Ultra-widefield fundus photograph:
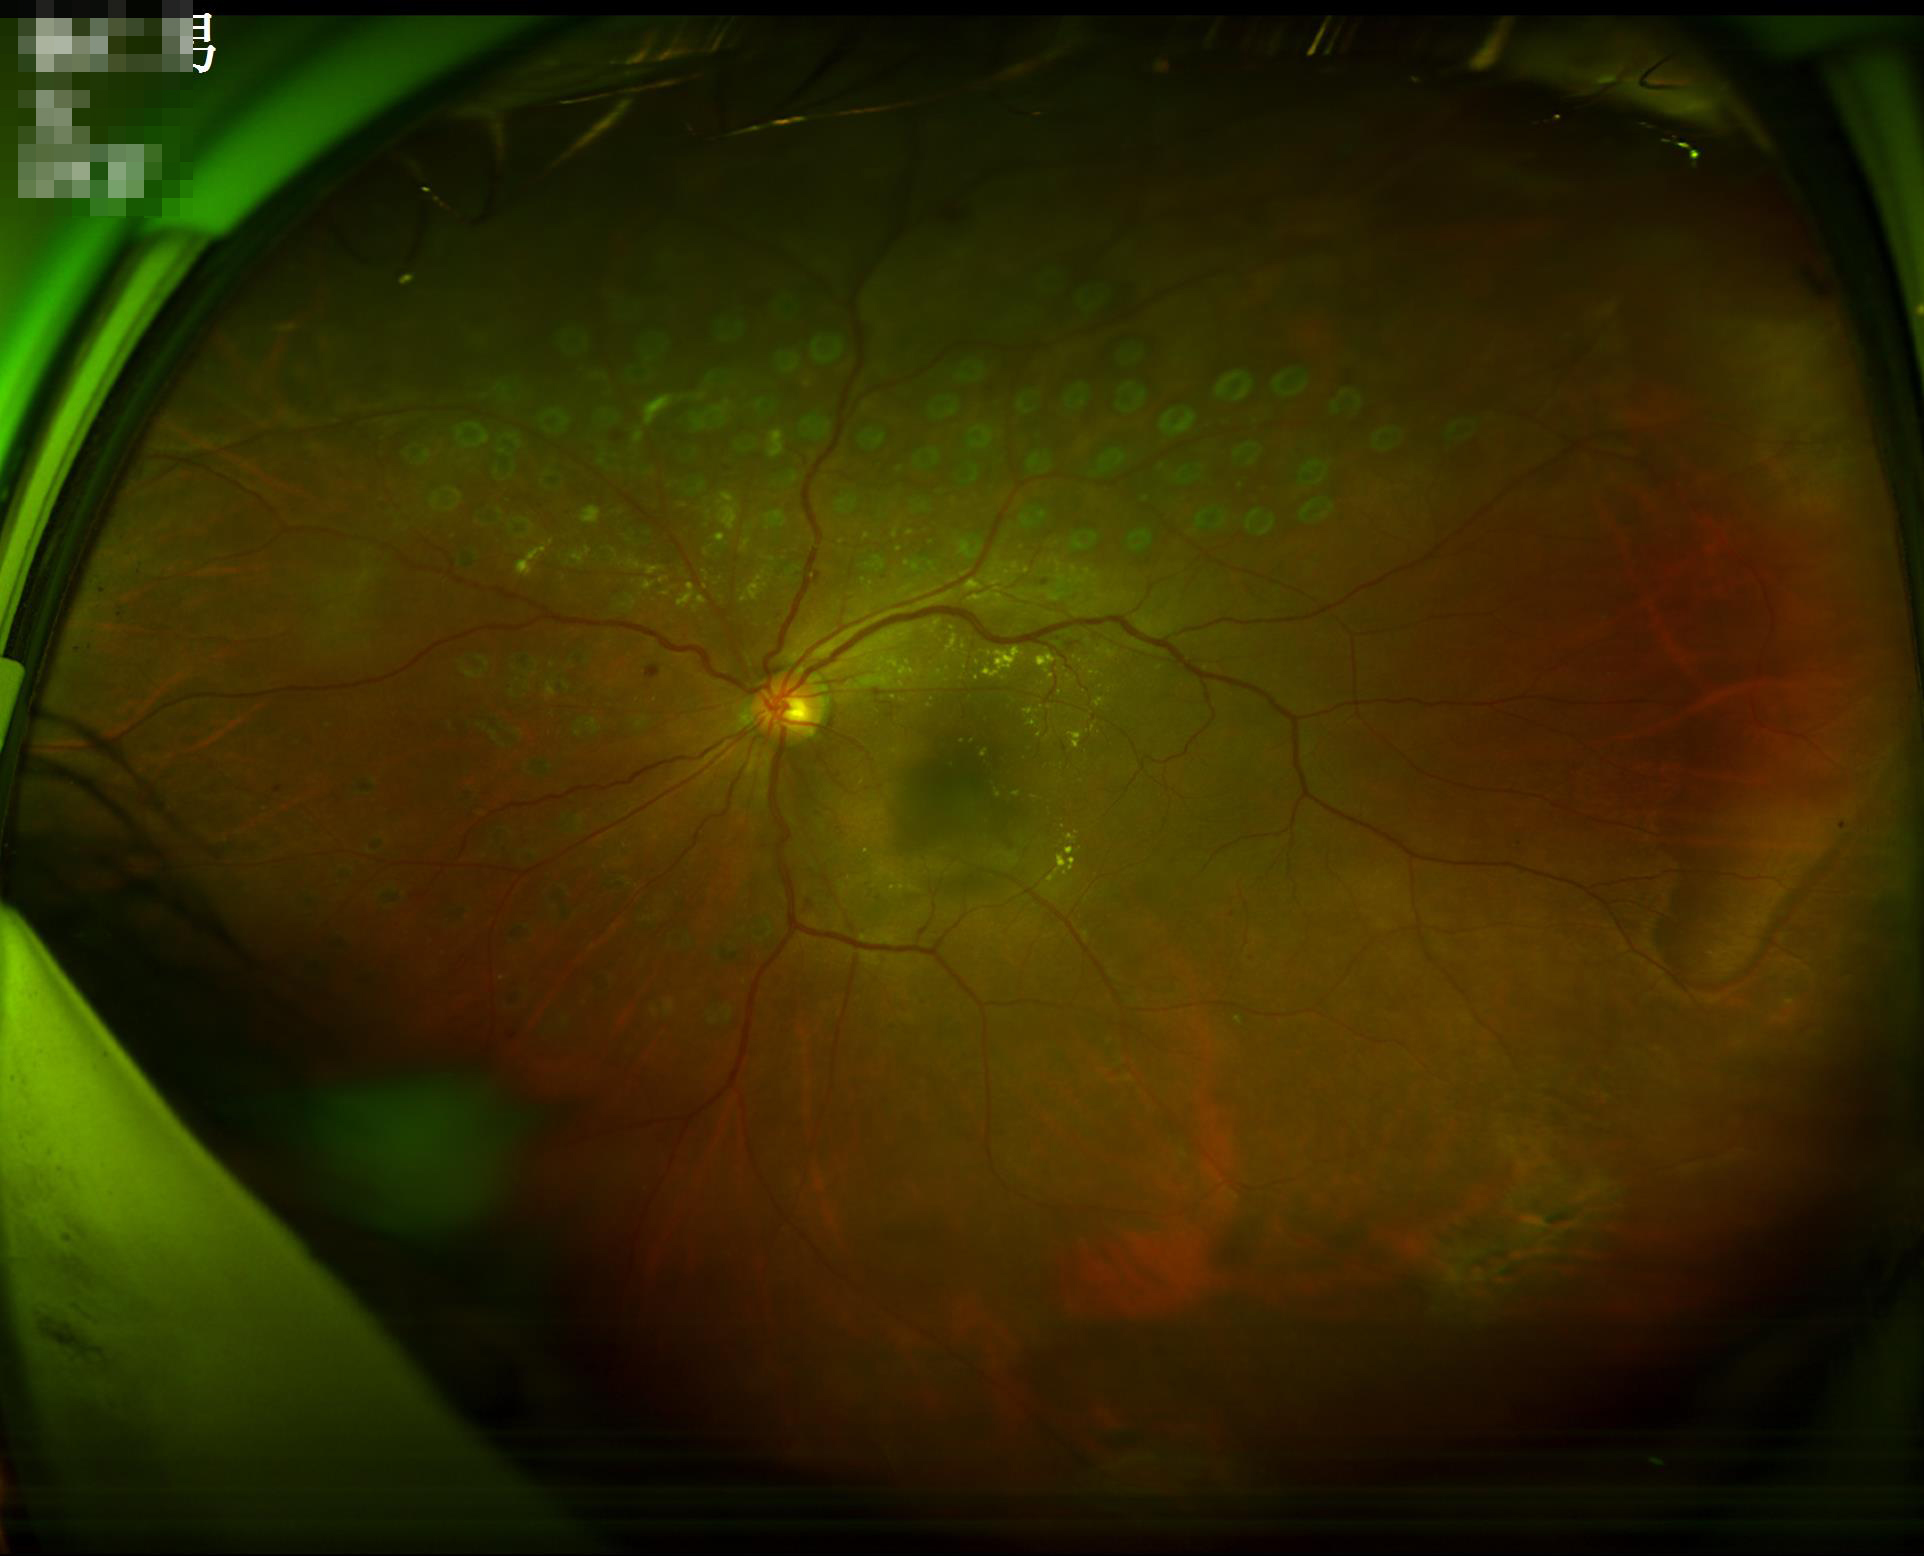

{
  "illumination": "adequate",
  "clarity": "clear",
  "overall_quality": "acceptable"
}